2102x1736px:
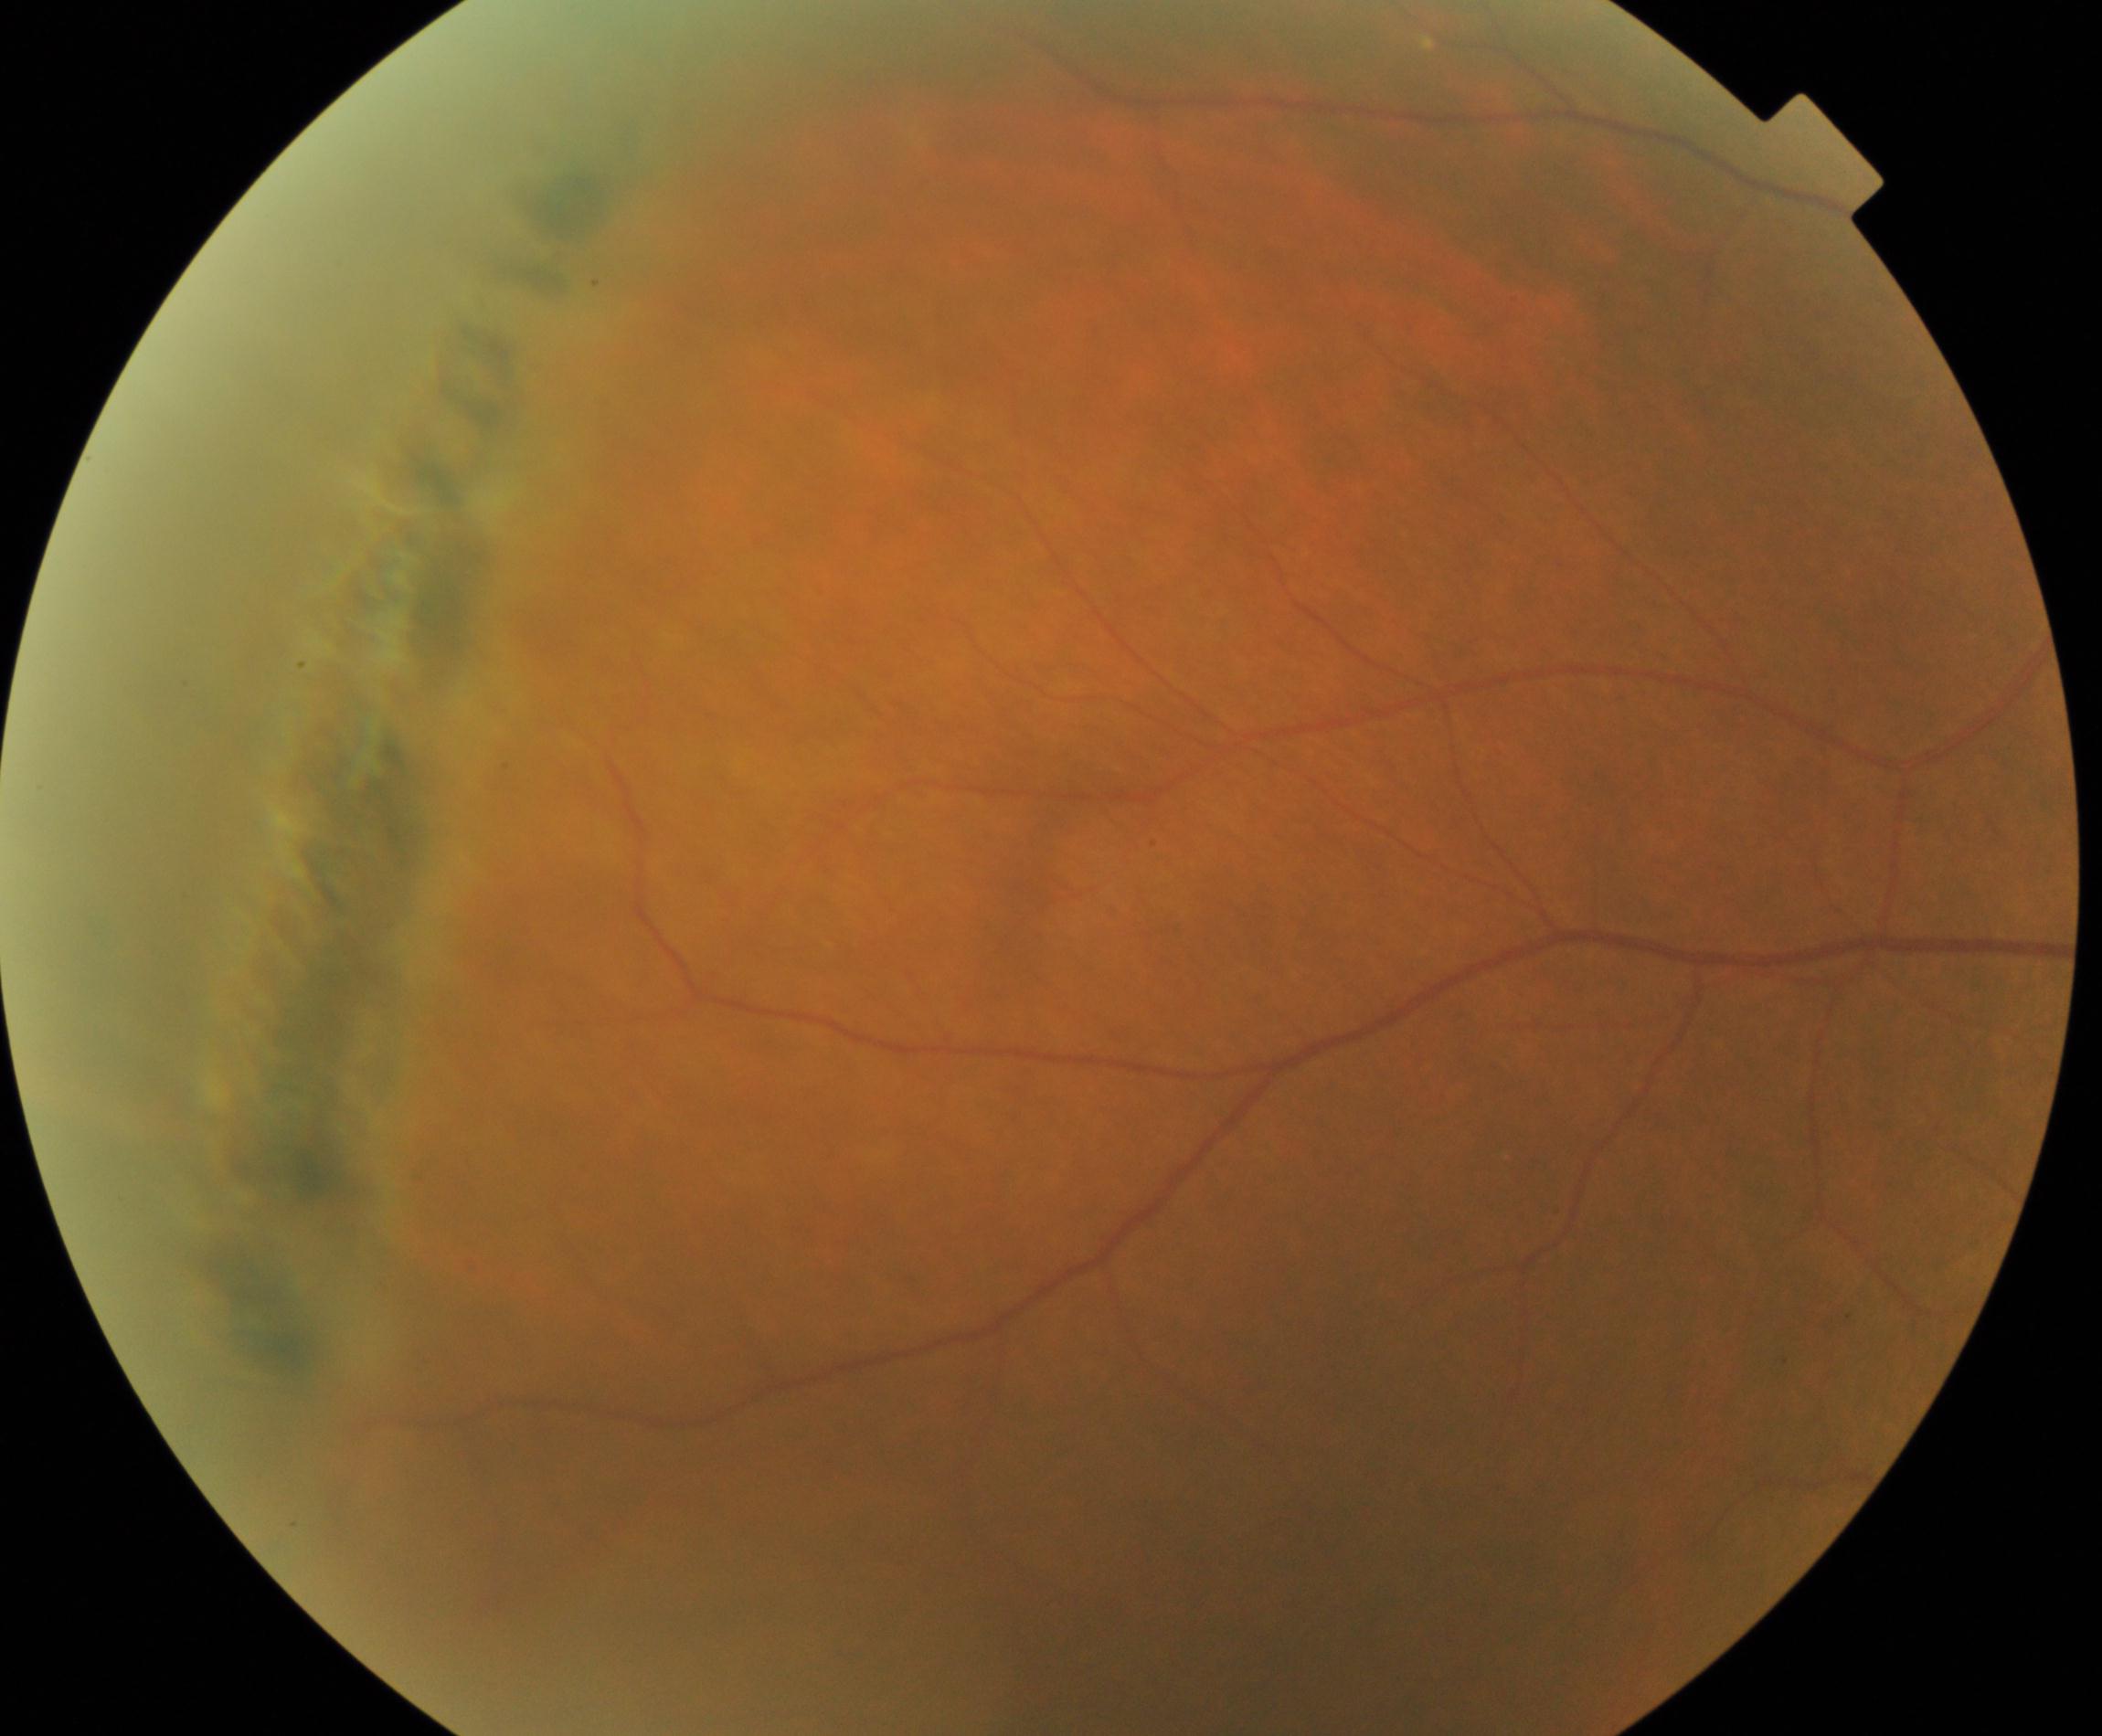
Diagnosis: peripheral retinal degeneration and break.